2352x1568px: 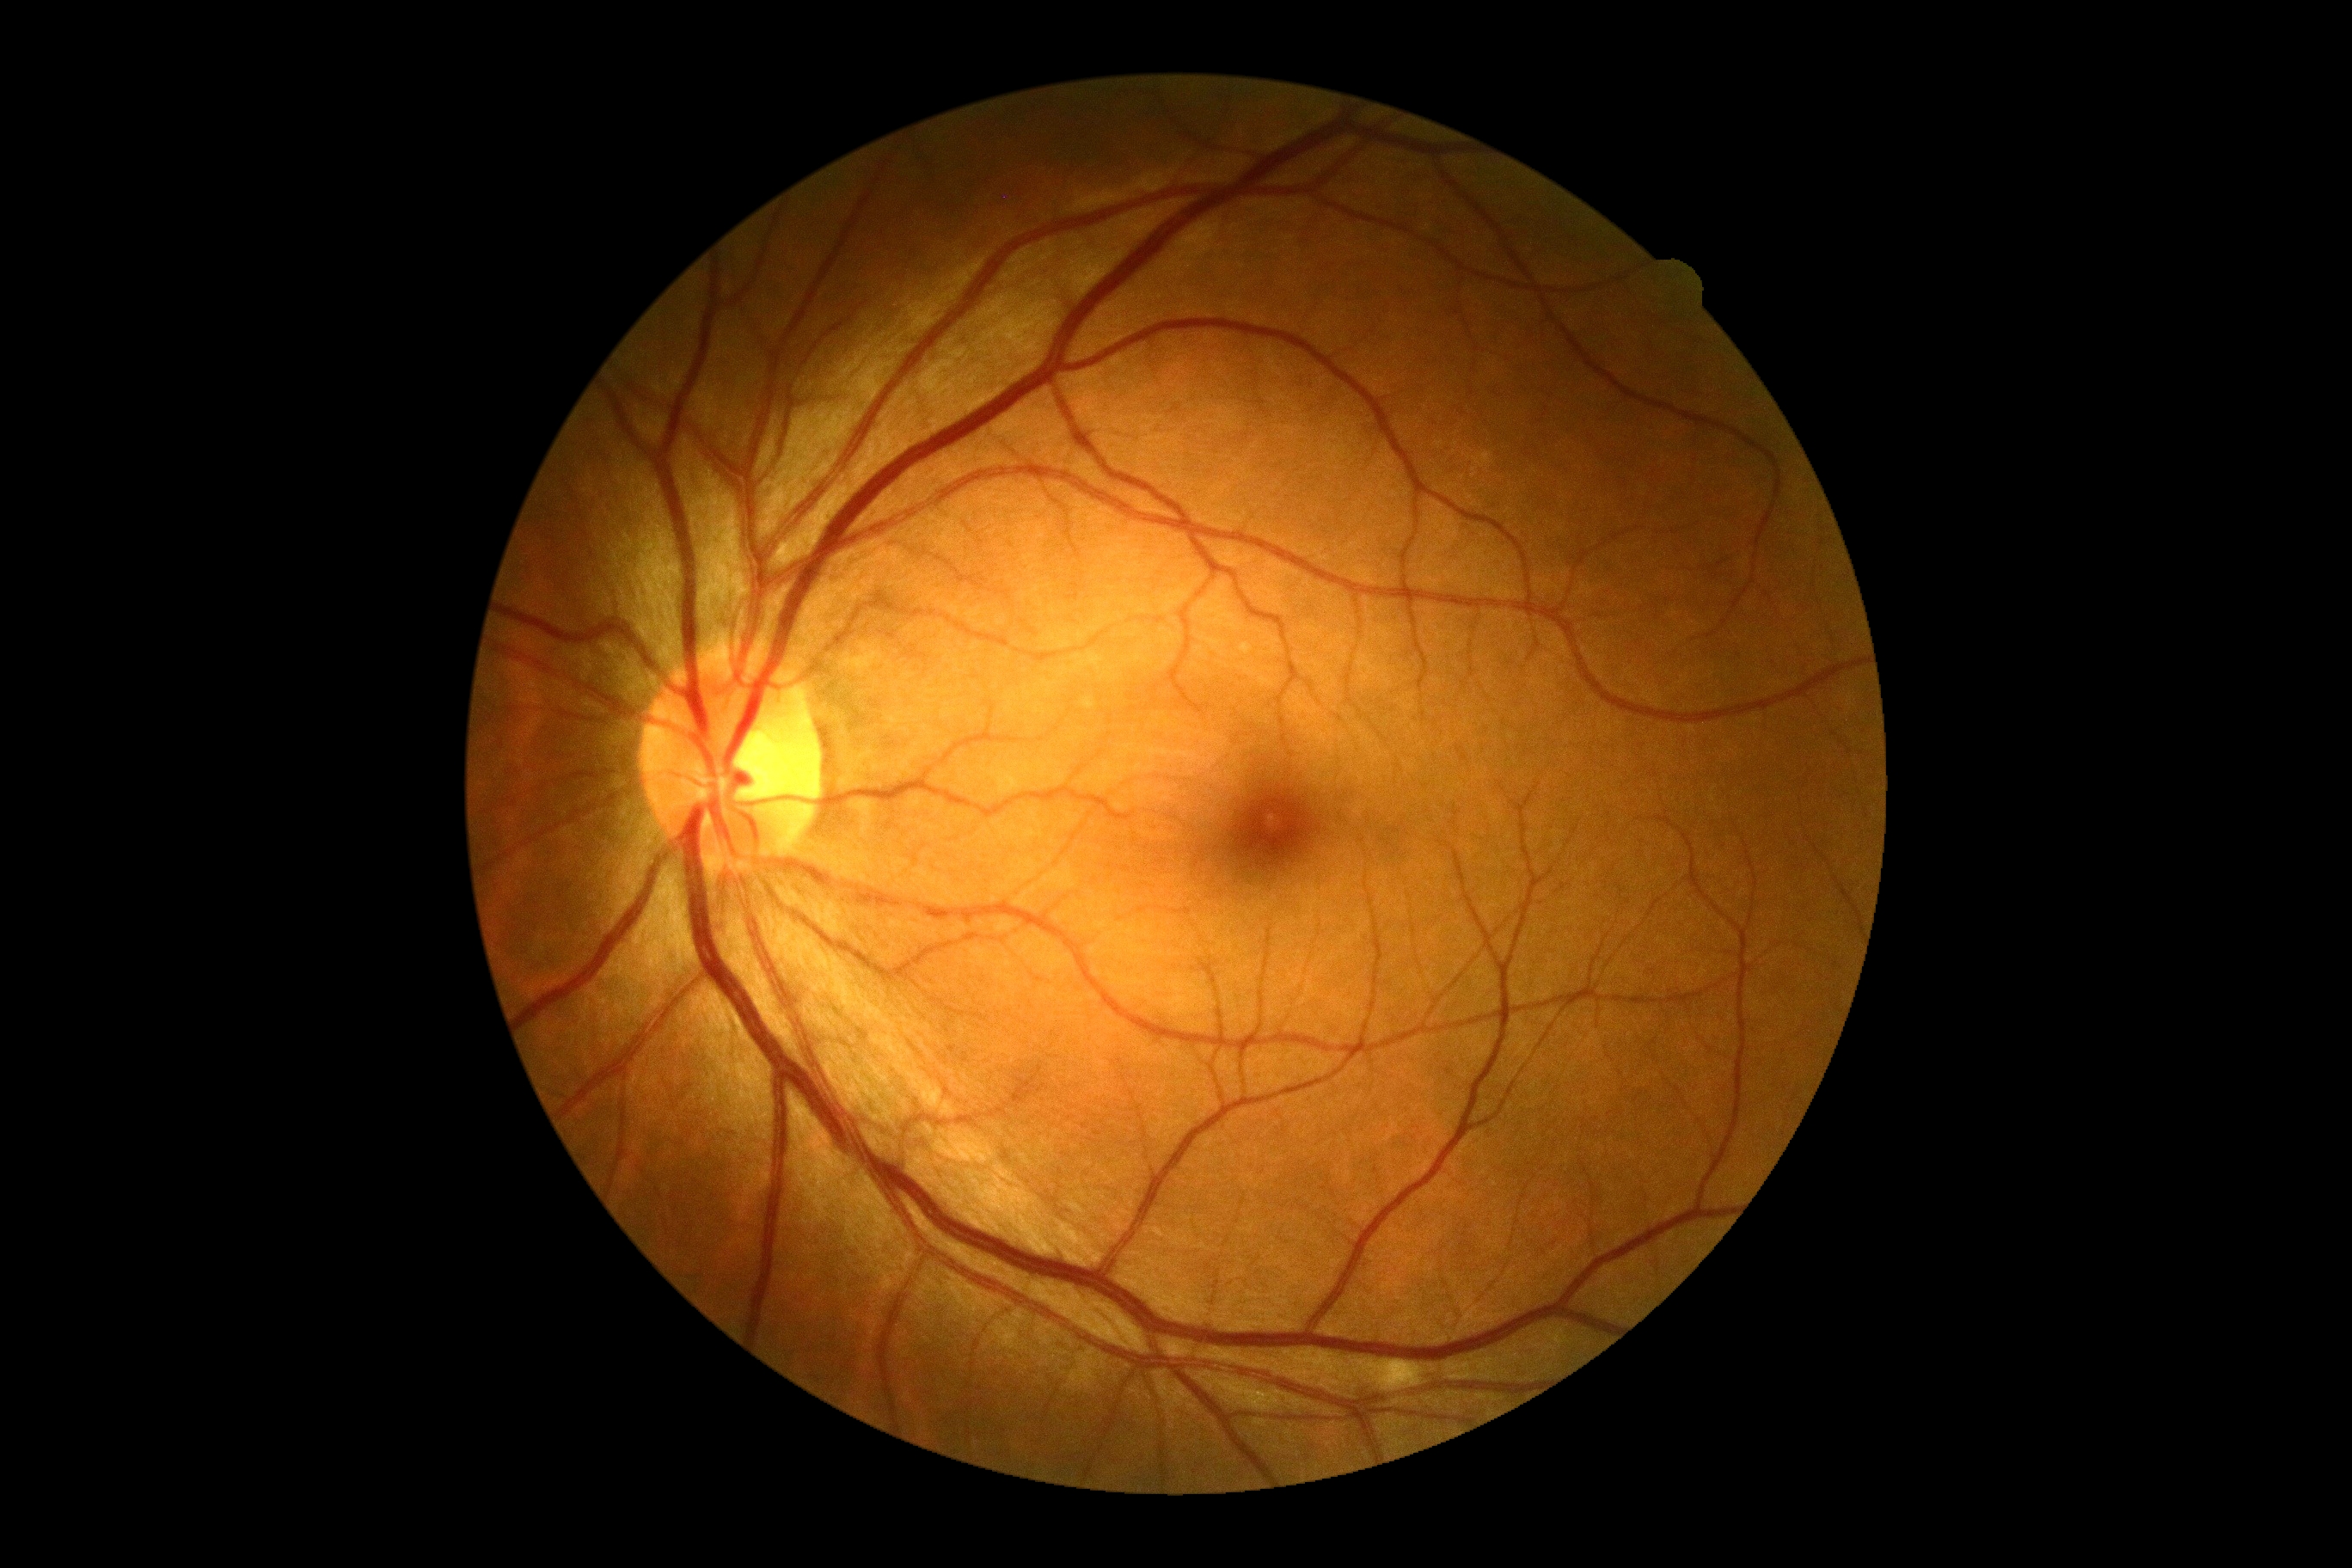 {
  "dr_grade": "moderate NPDR (2)"
}